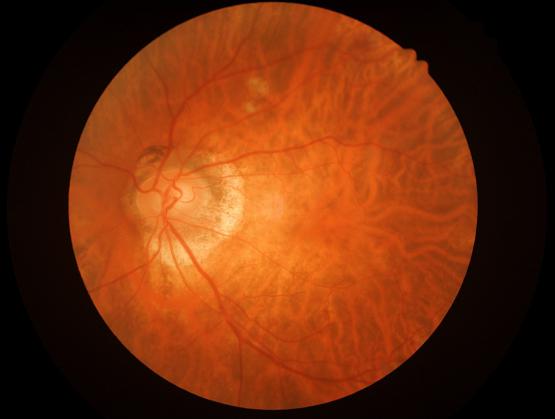

Quality assessment: clarity: blurry | illumination: good | contrast: good | overall: adequate.